CFP, 1380 x 1382 pixels, 45° FOV — 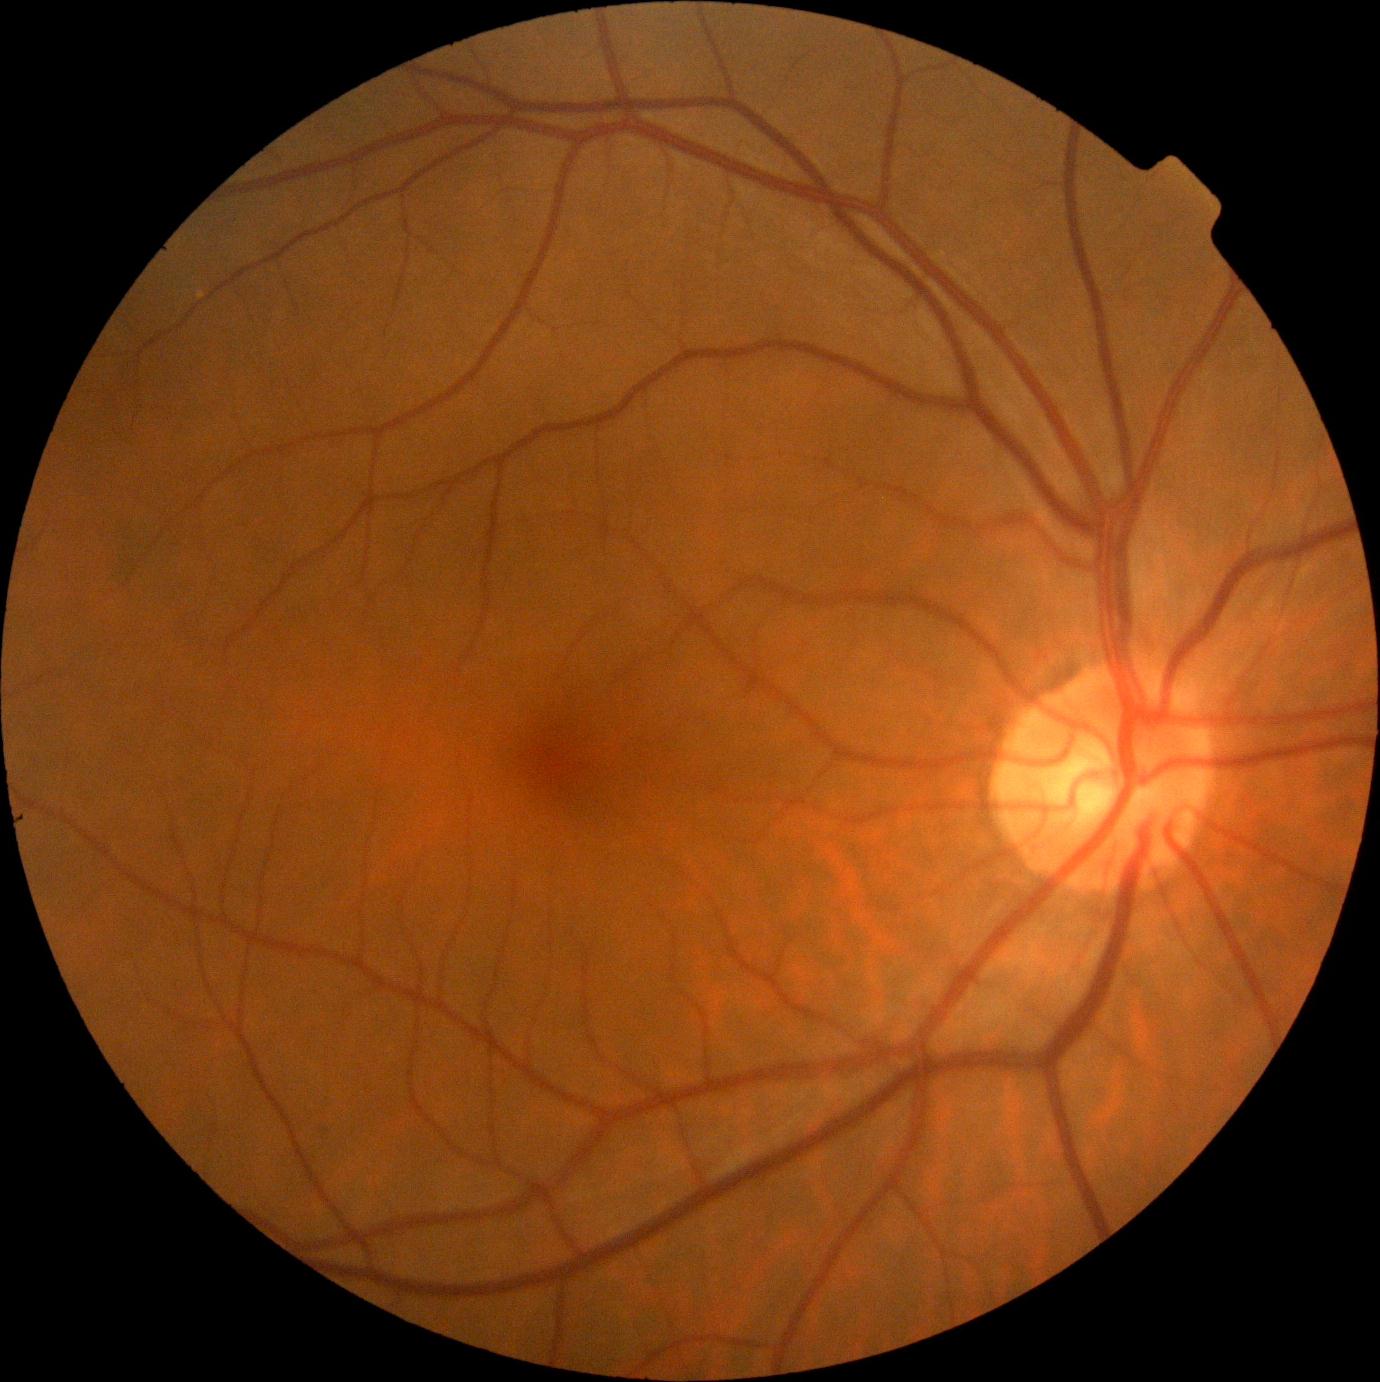 Annotations:
- DR grade: 0 (no apparent retinopathy)